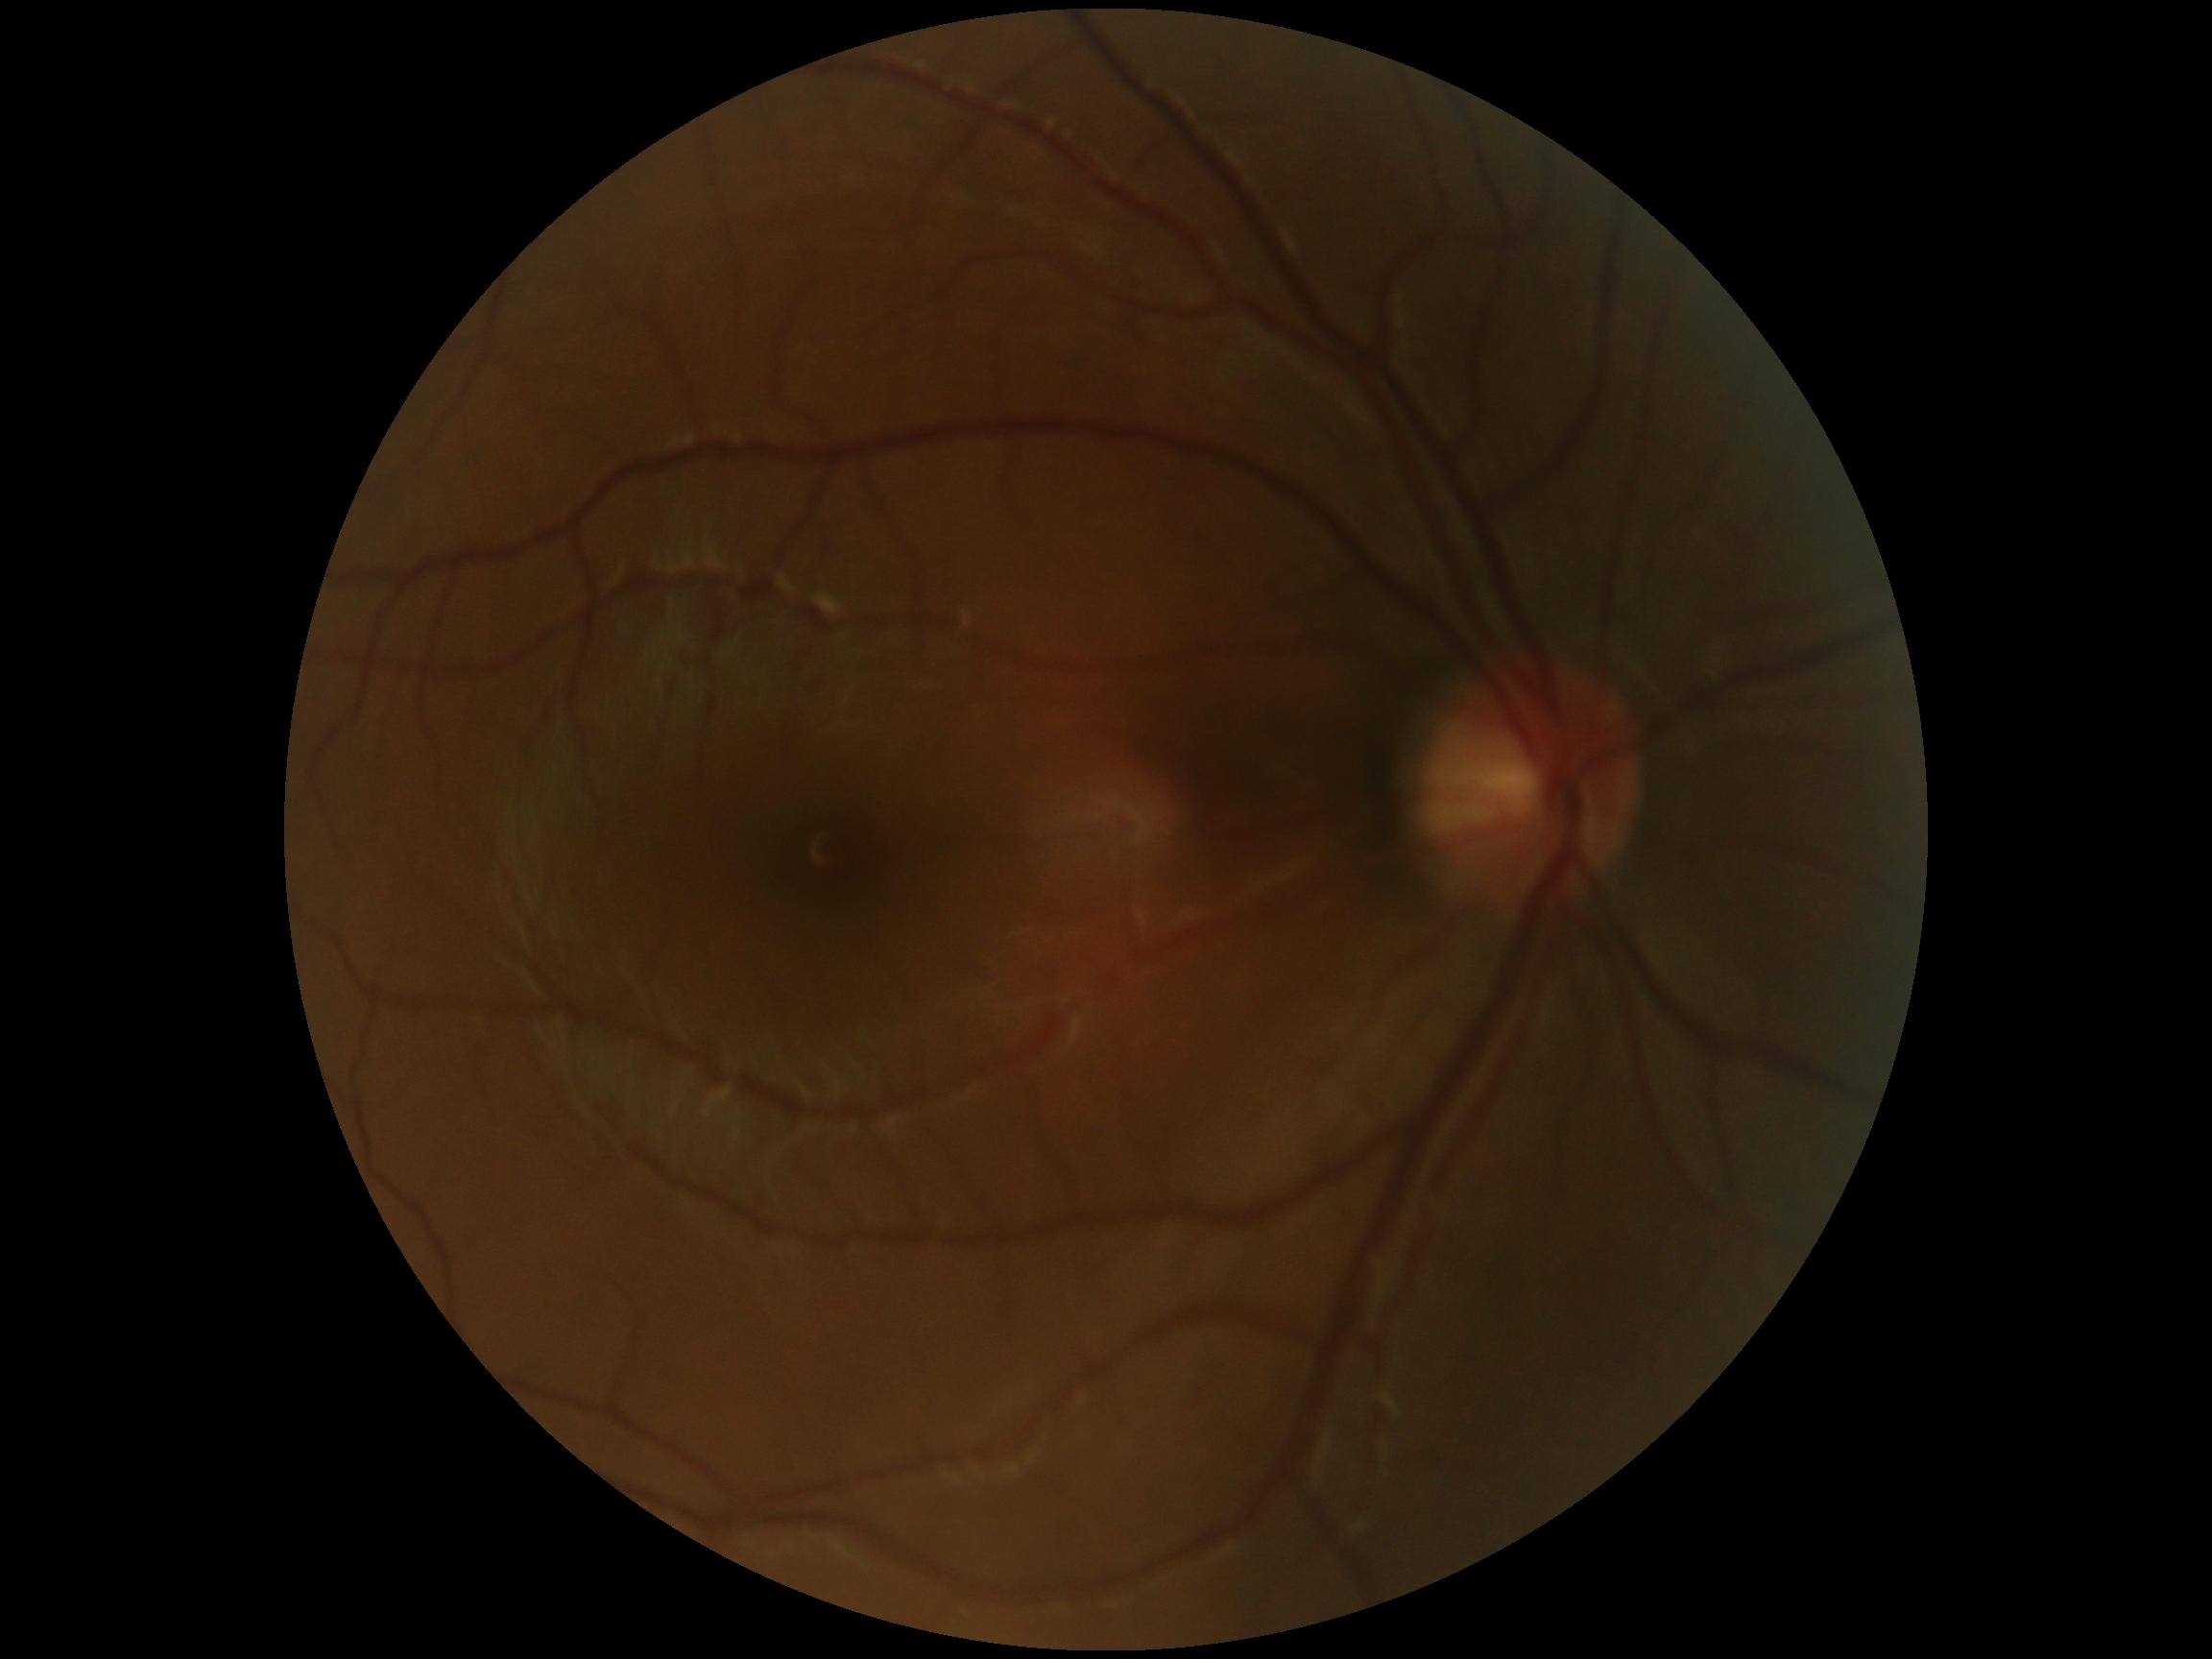
Diabetic retinopathy severity is grade 0 (no apparent retinopathy) — no visible signs of diabetic retinopathy.